Infant wide-field fundus photograph; 130° field of view (Clarity RetCam 3).
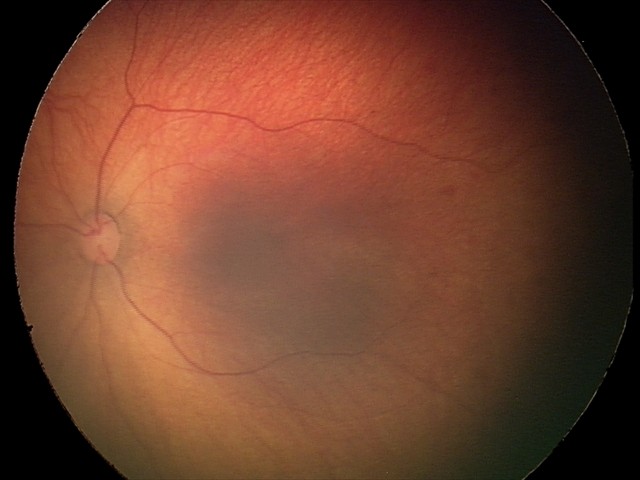

Screening diagnosis: retinal hemorrhages.